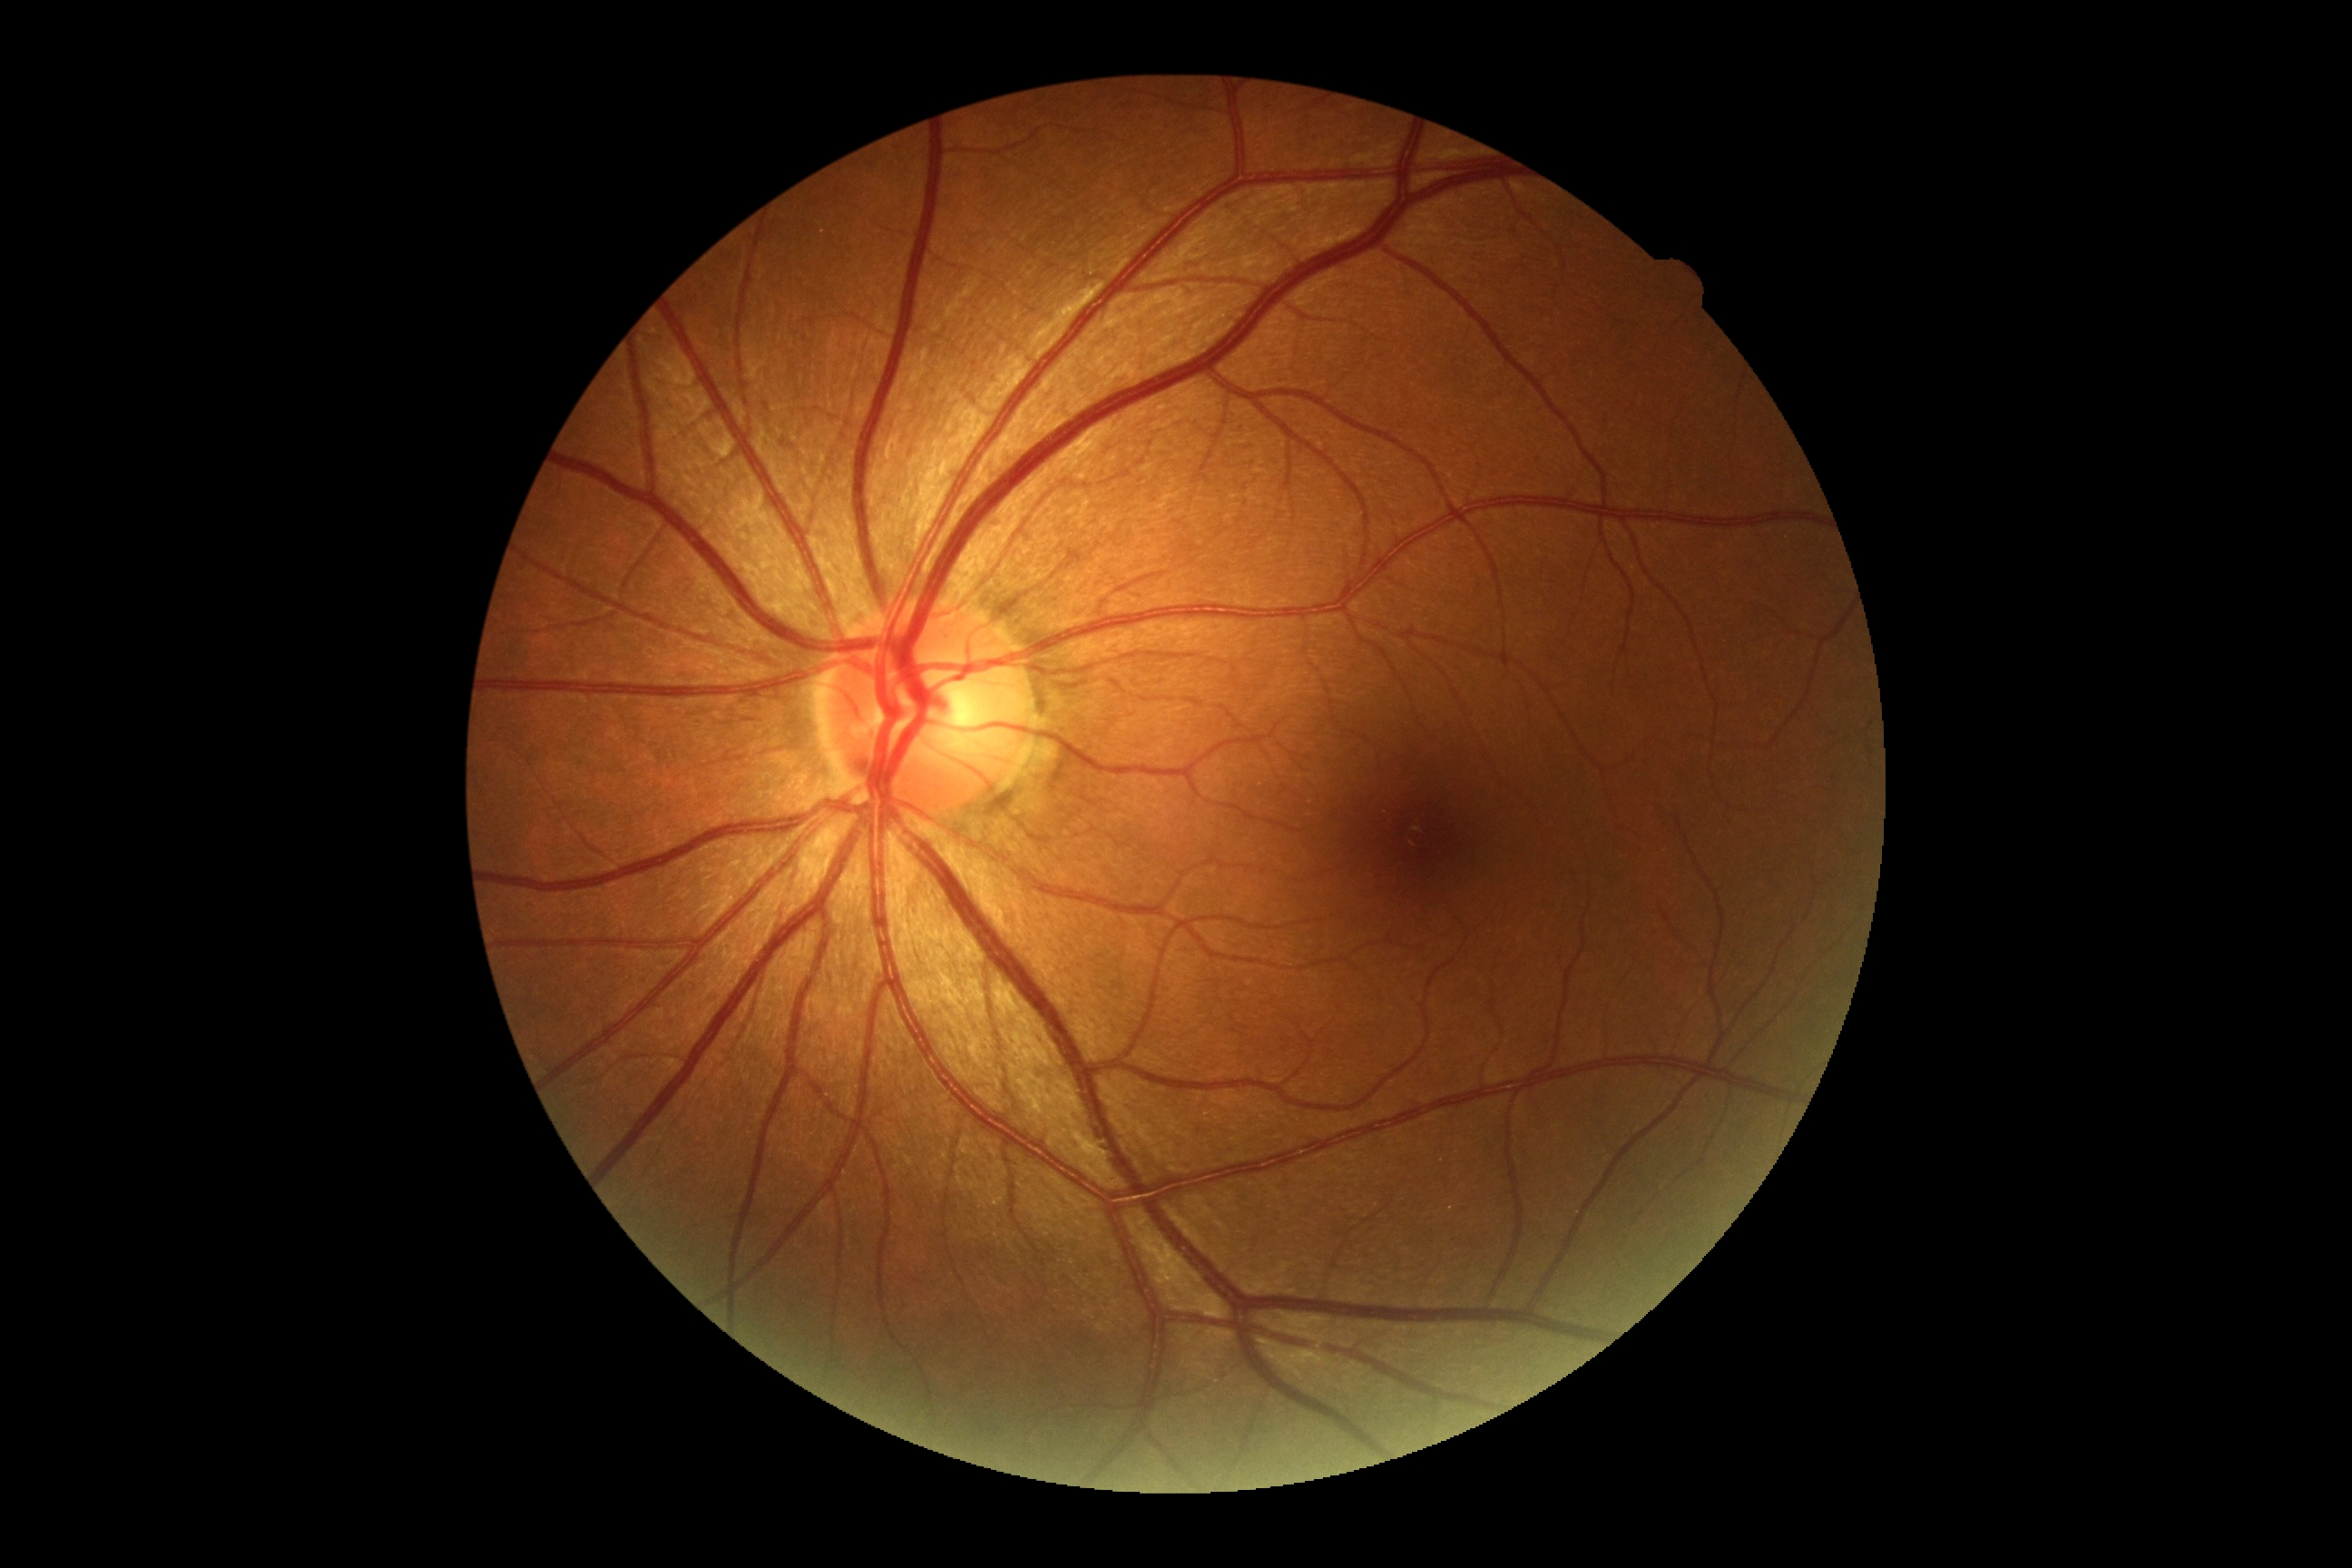 DR = grade 0 (no apparent retinopathy)